Infant wide-field fundus photograph — 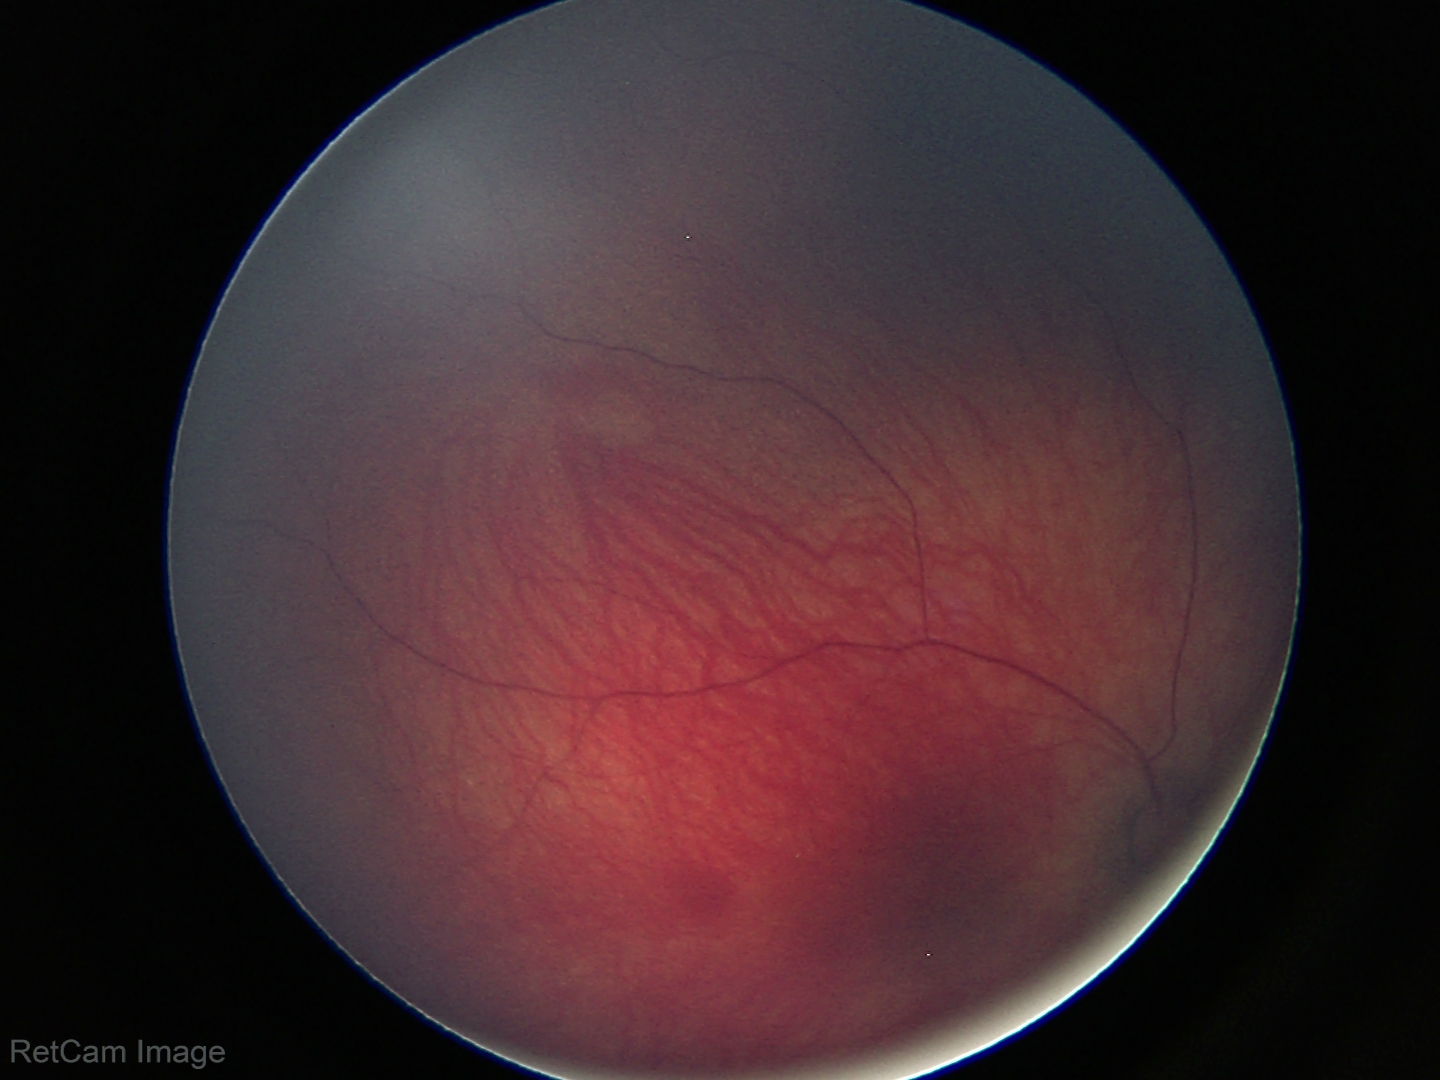

Screening examination diagnosed as physiological.